45-degree field of view · nonmydriatic
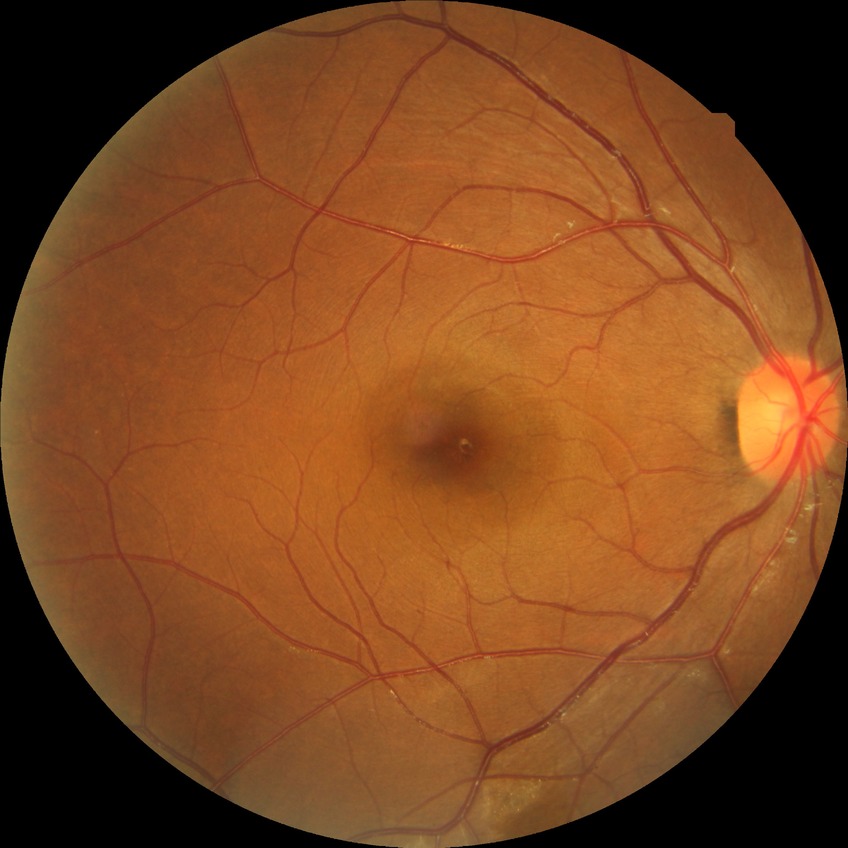

Diabetic retinopathy (DR) is SDR (simple diabetic retinopathy).